Retinal fundus photograph — 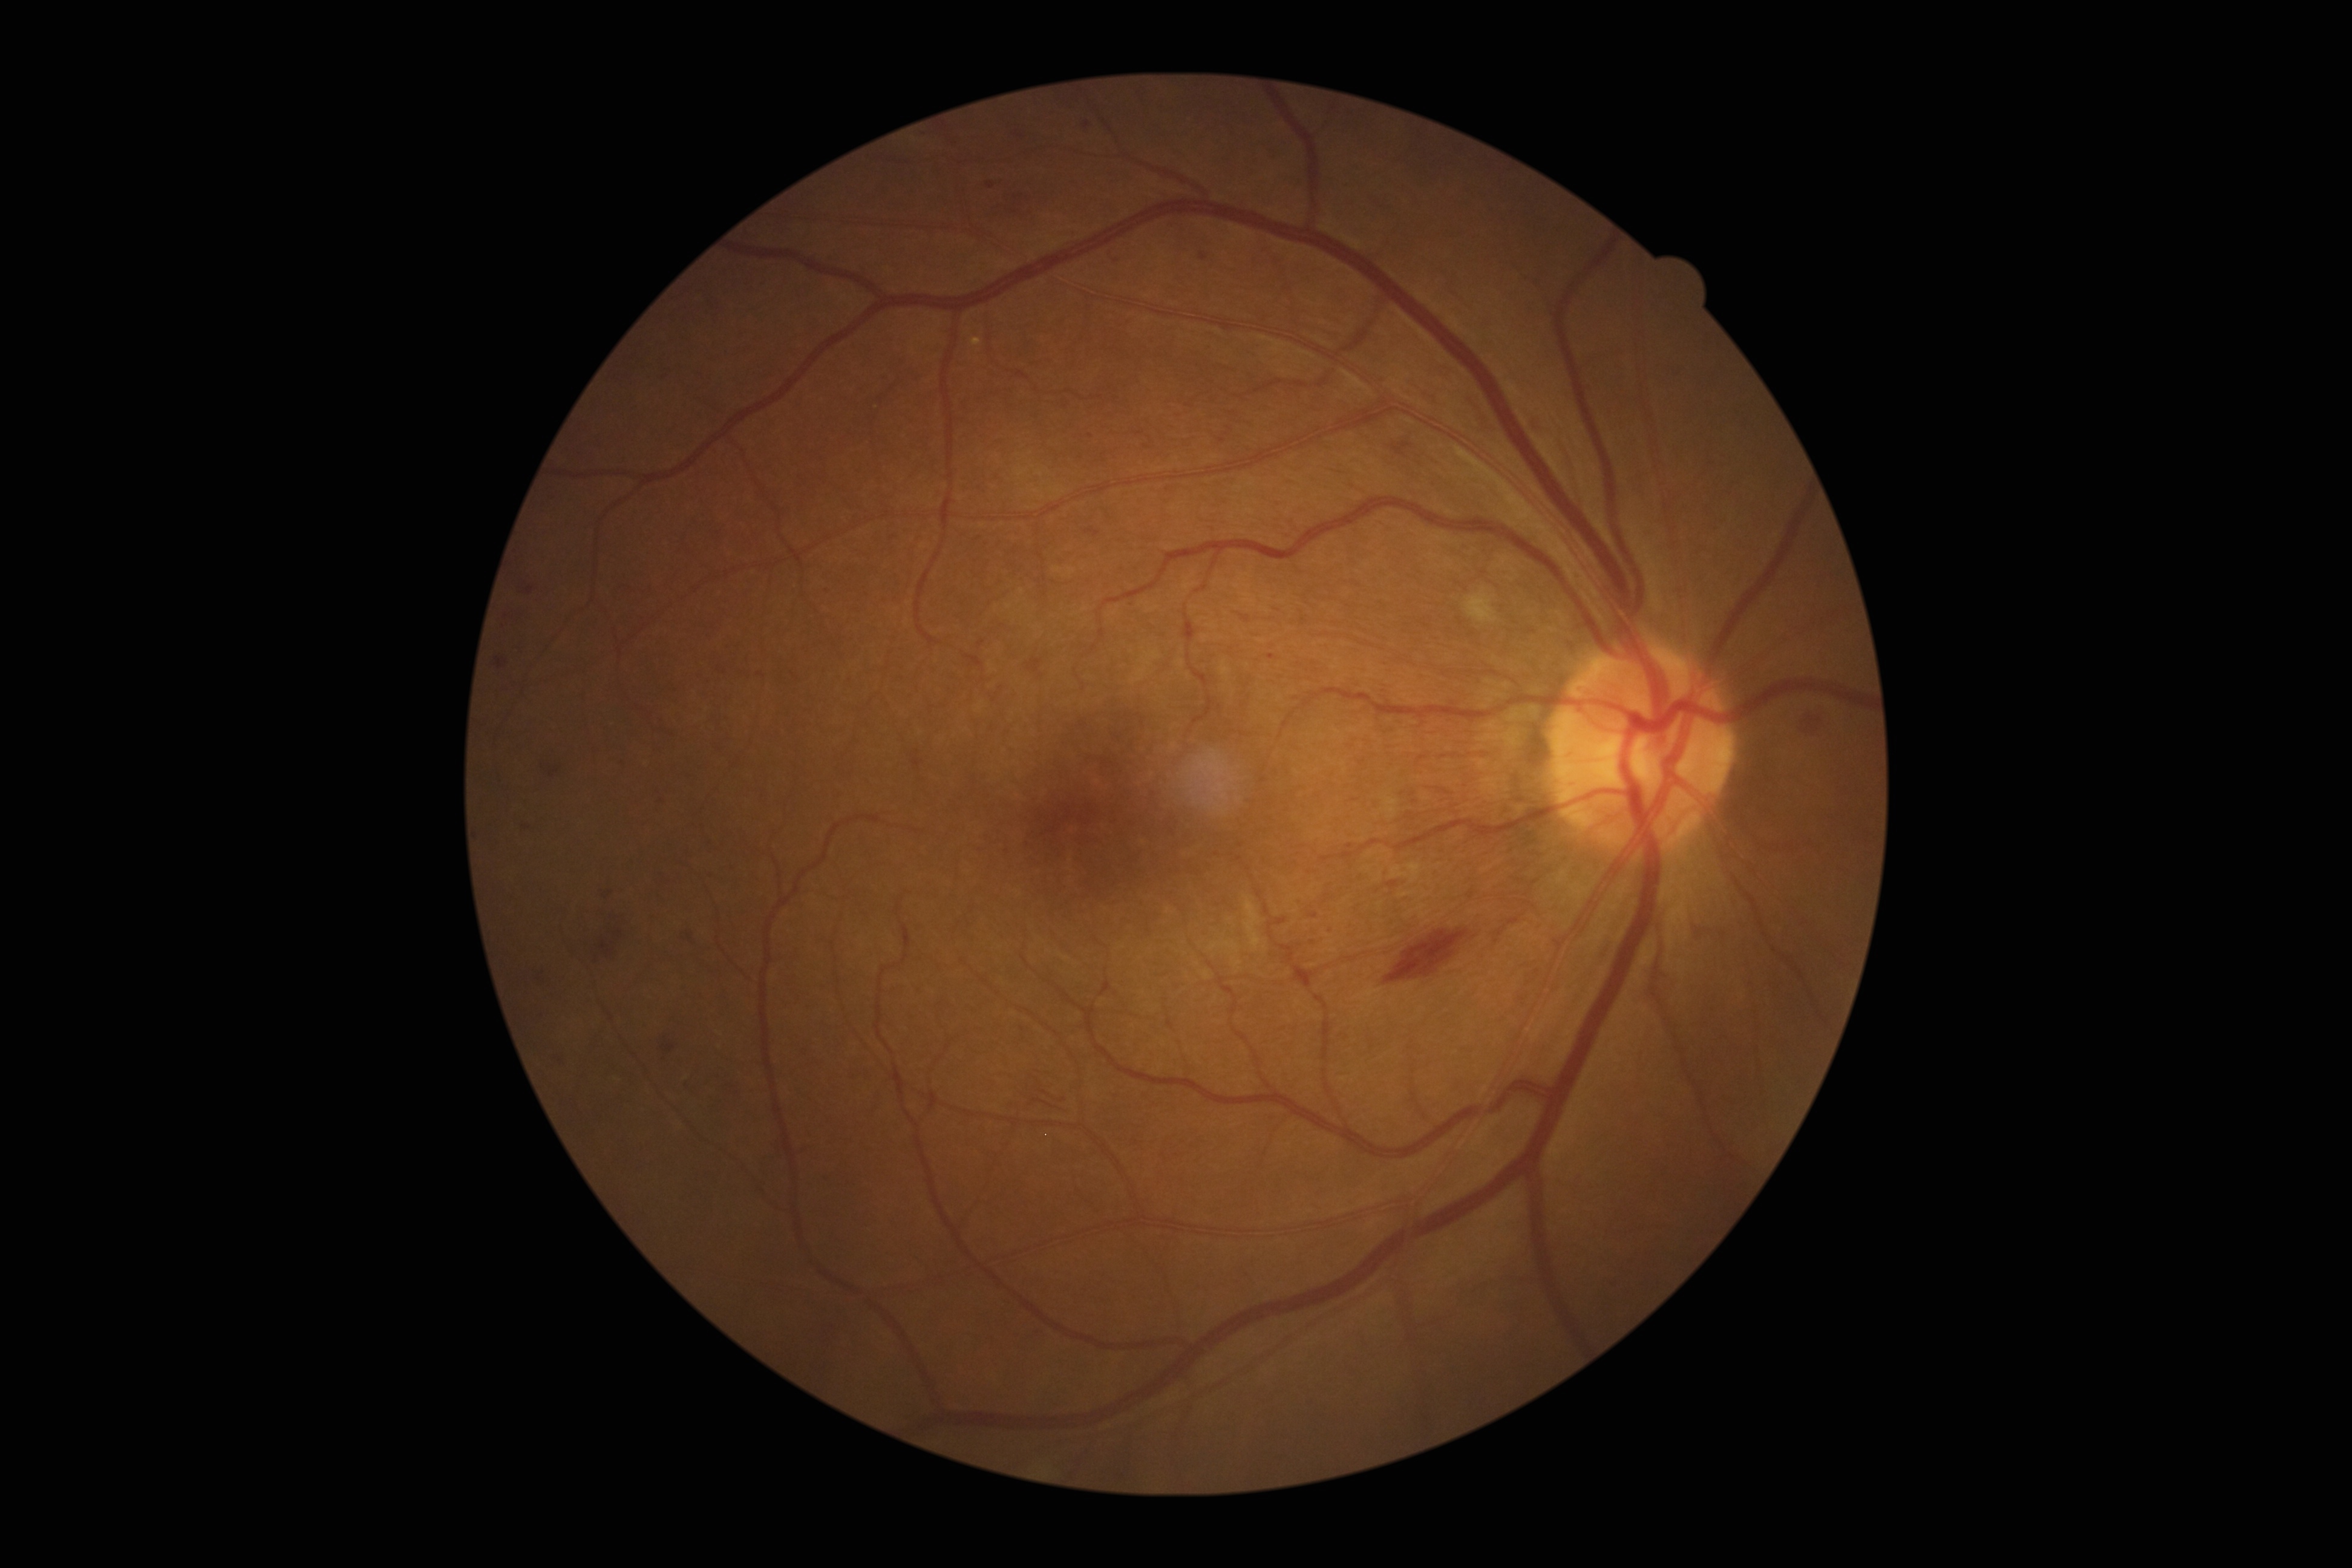 {
  "dr_grade": "grade 2 (moderate NPDR)"
}